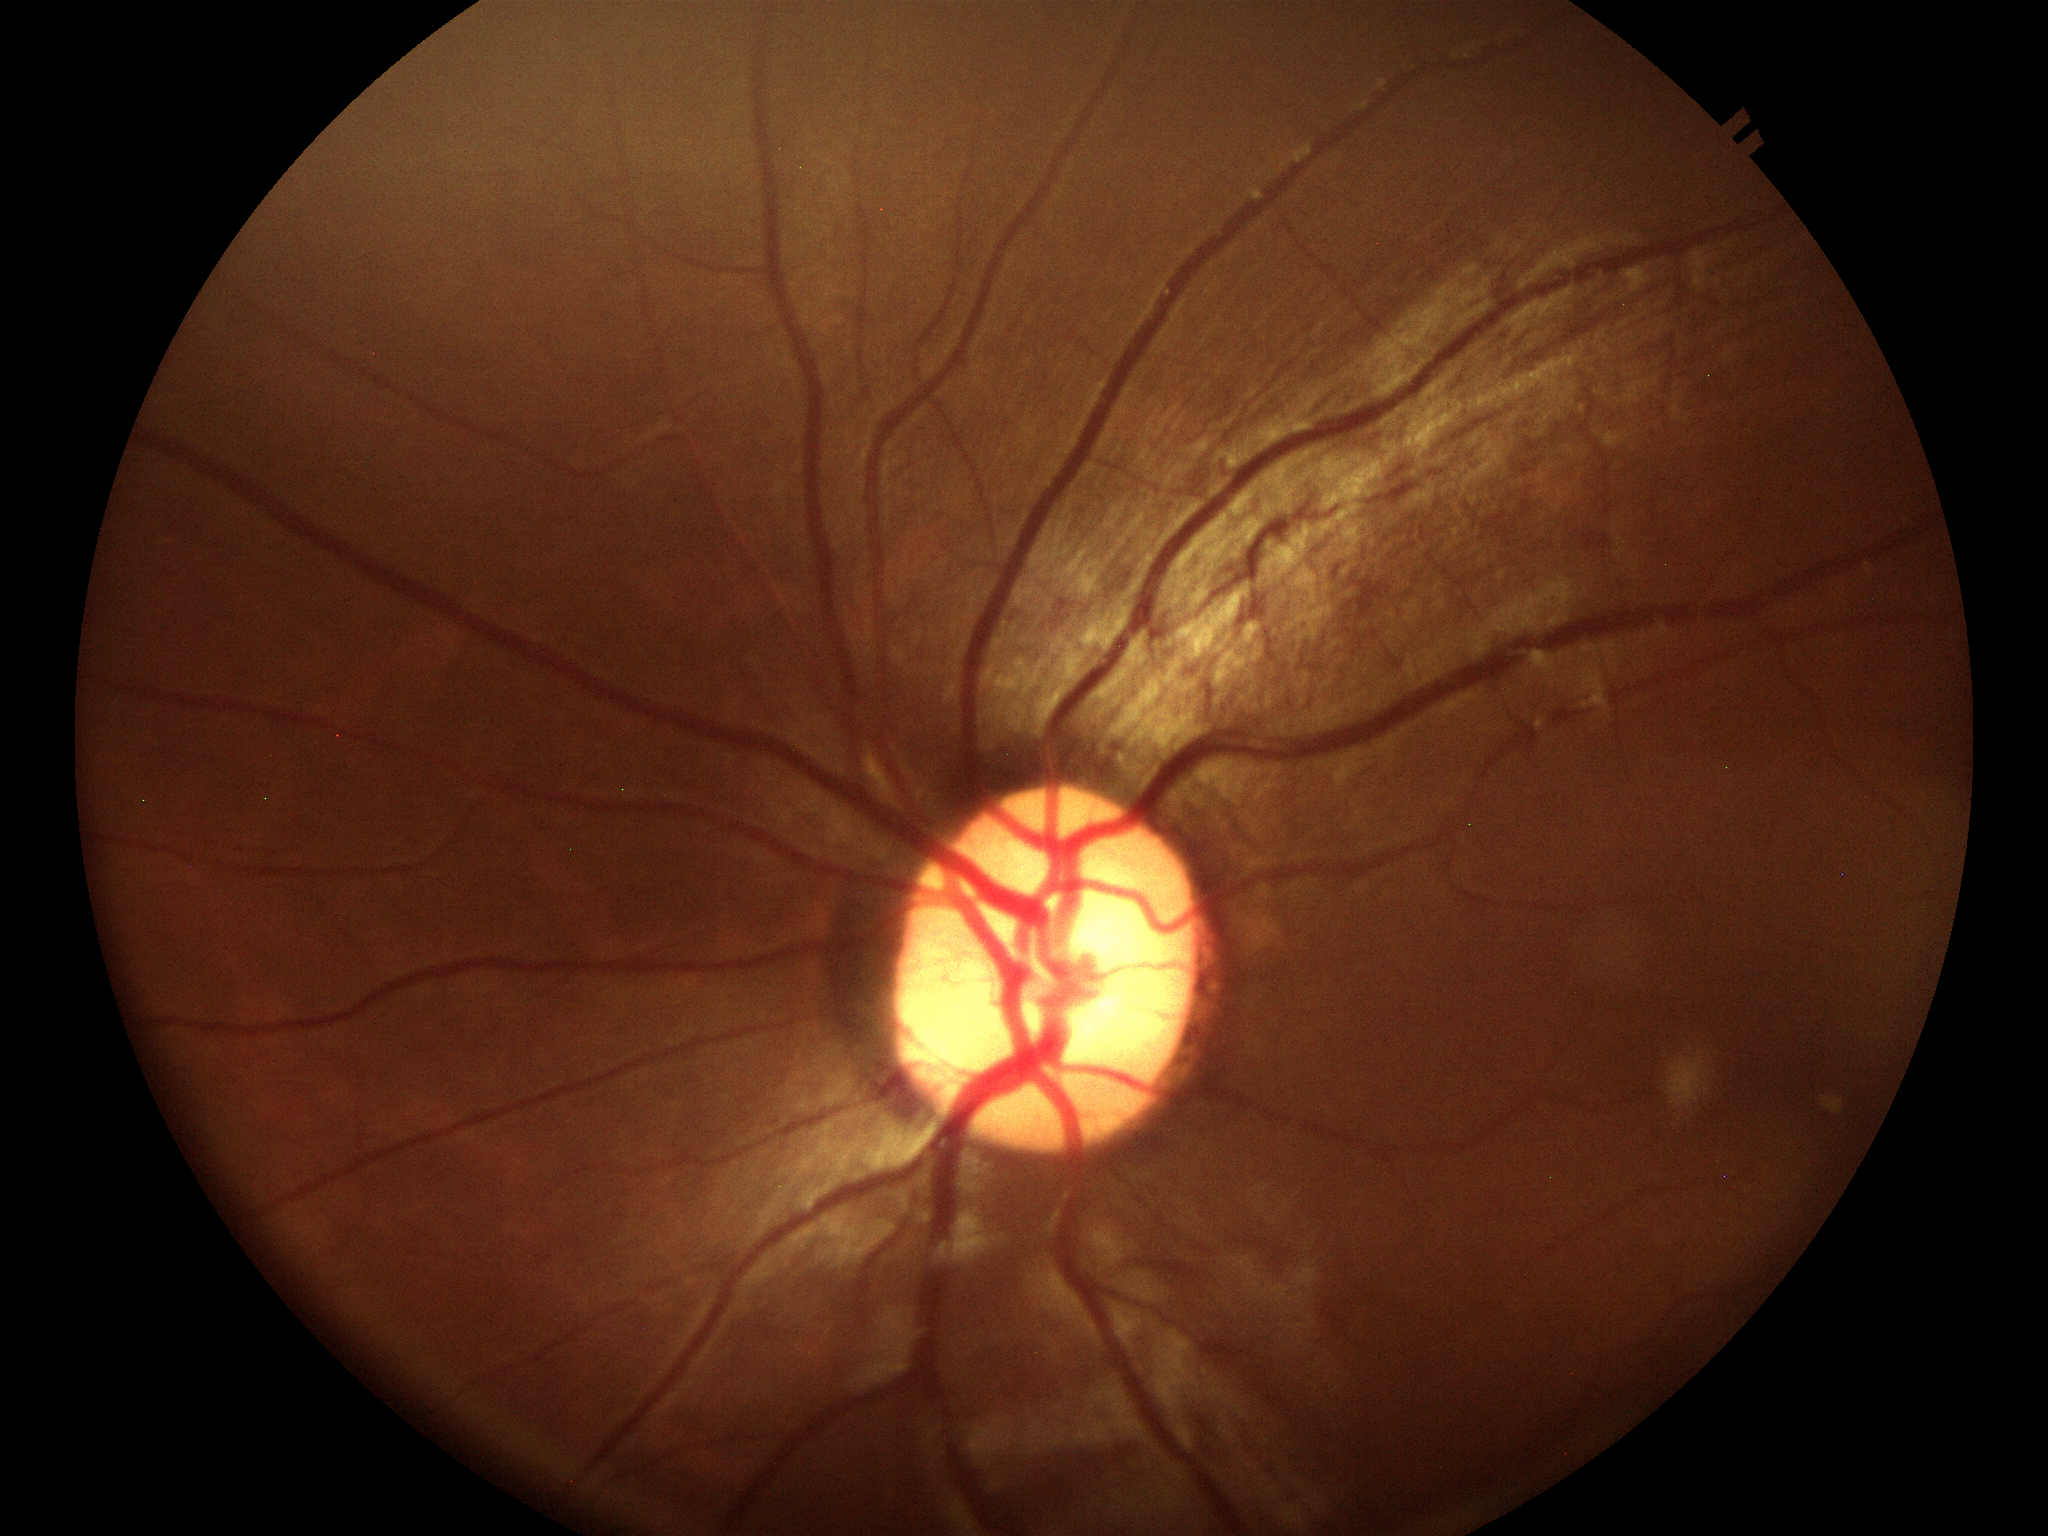

vcdr: 0.59
glaucoma_decision: not suspect